45-degree field of view.
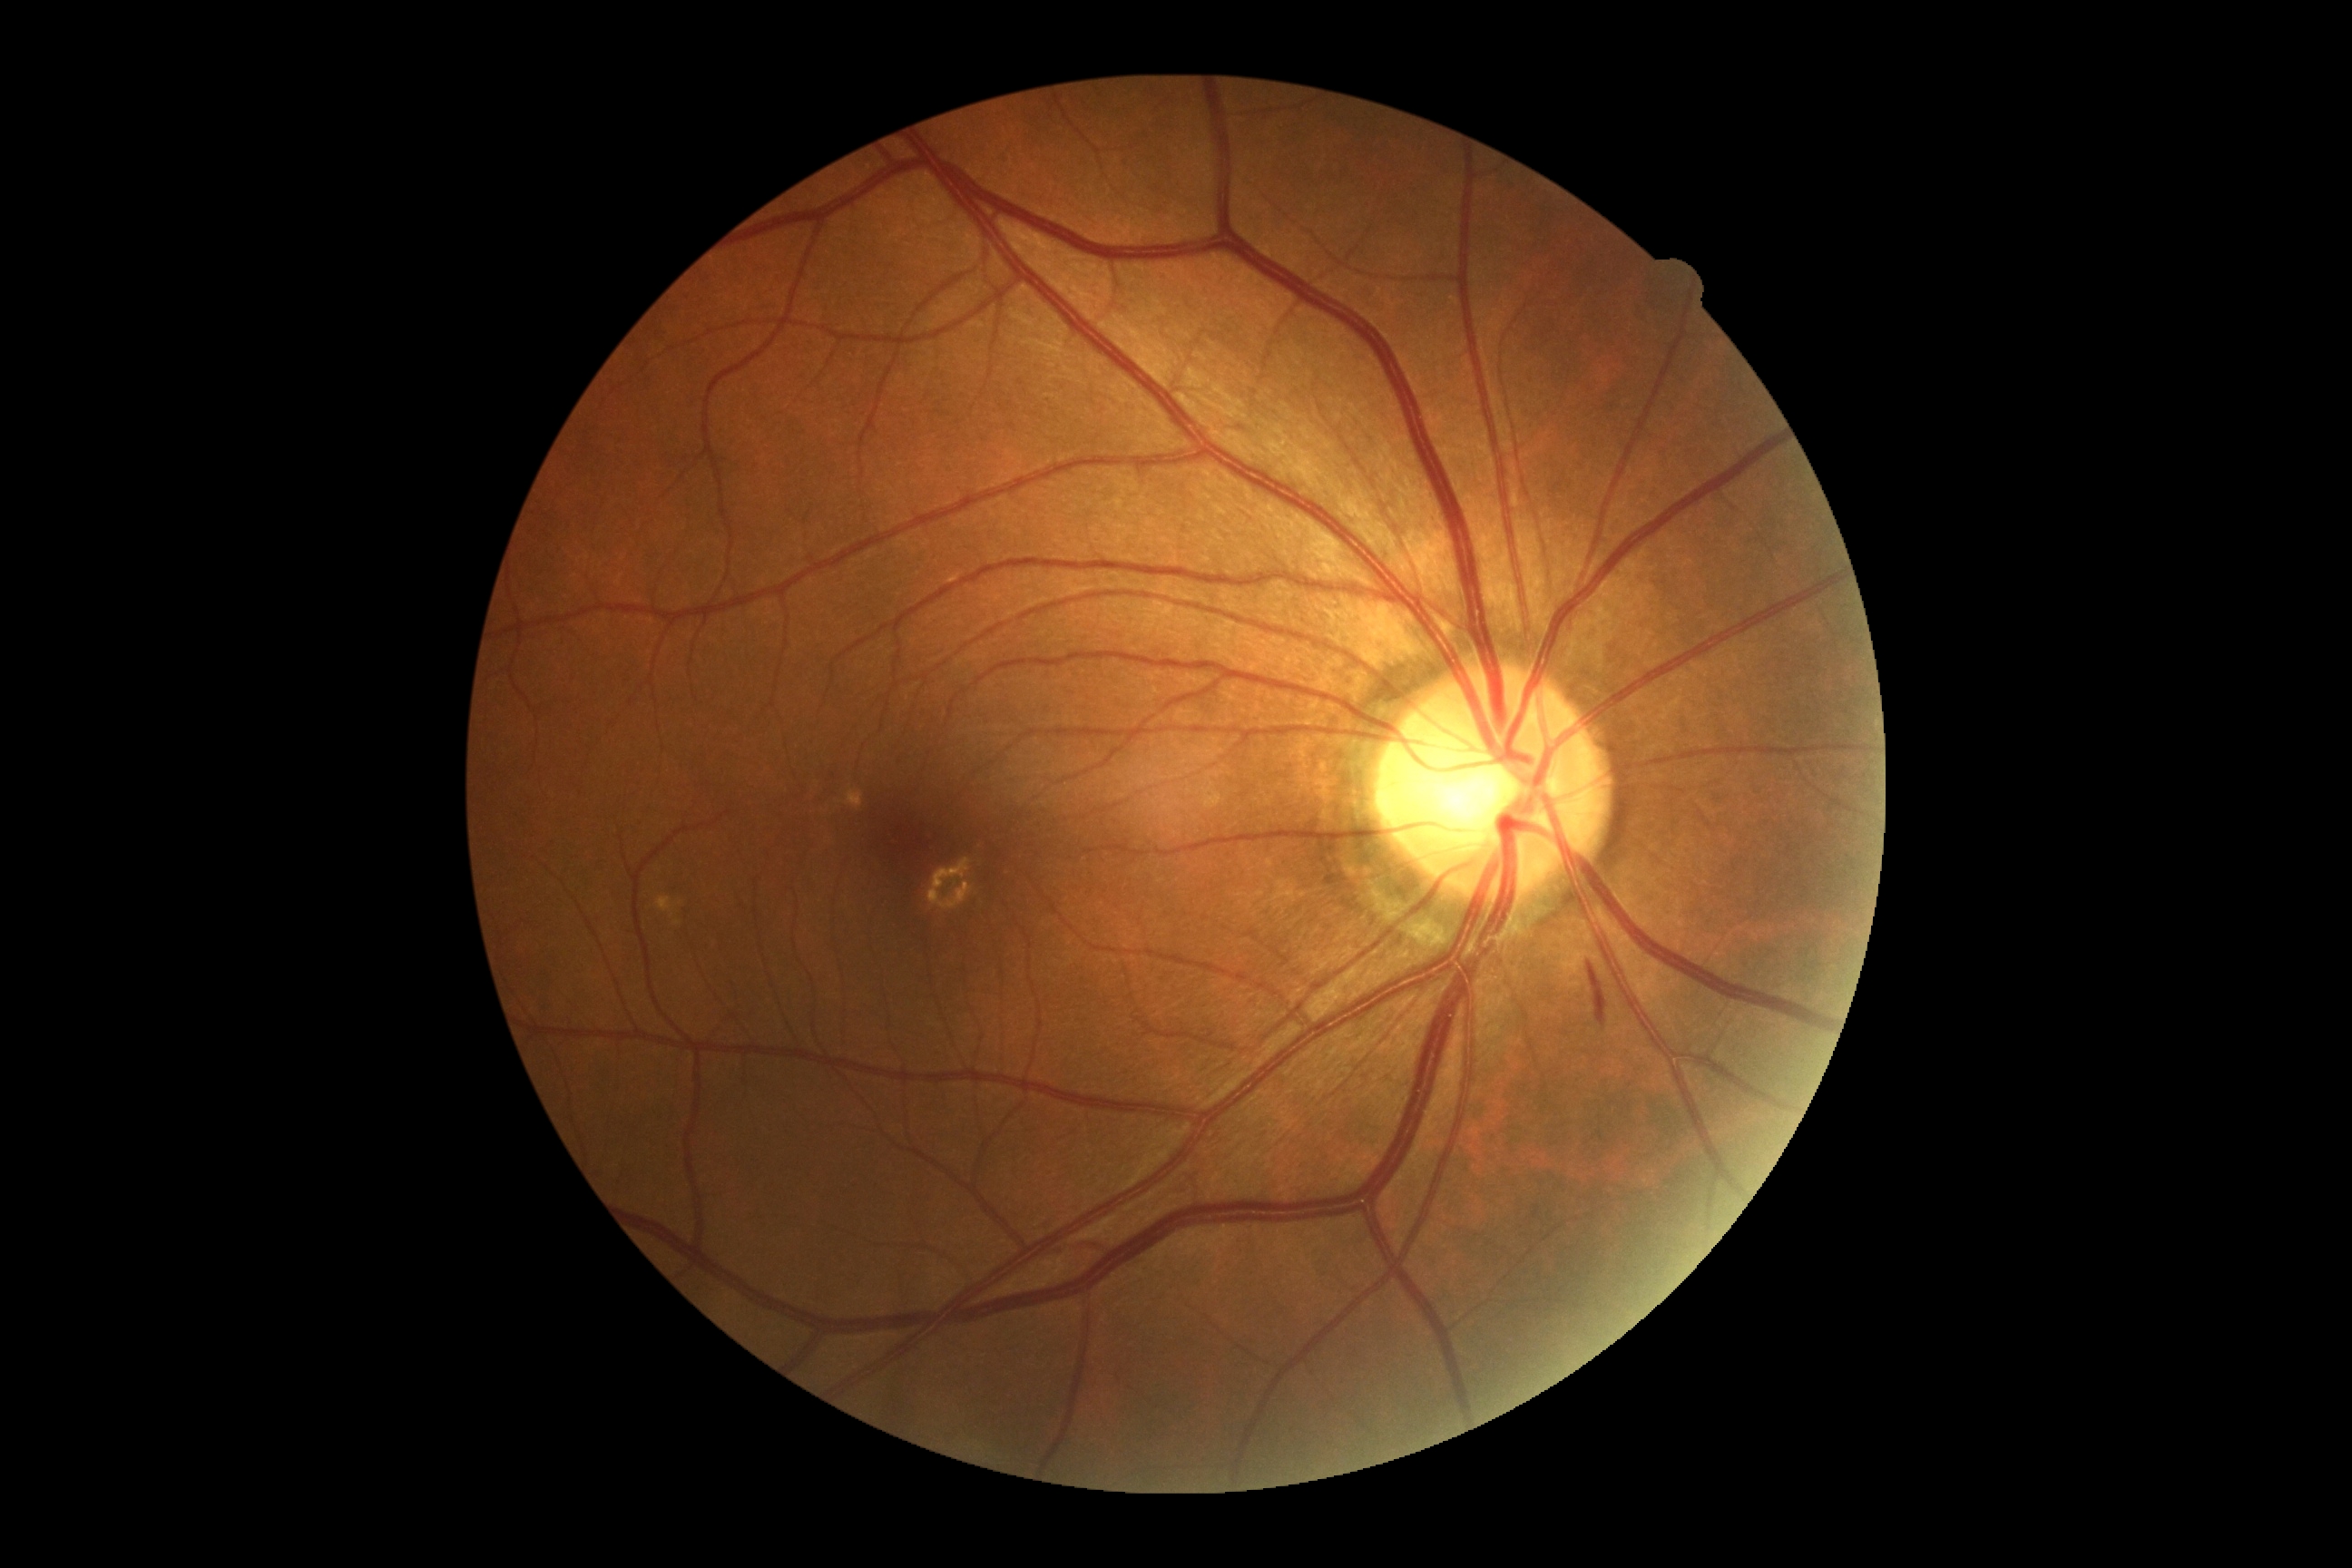 The retinopathy is classified as non-proliferative diabetic retinopathy. DR: grade 2 (moderate NPDR).